Wide-field fundus image from infant ROP screening. Clarity RetCam 3, 130° FOV. 640x480px — 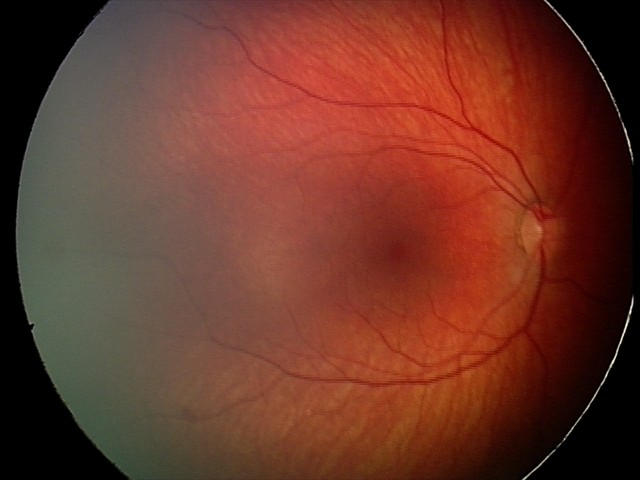

Series diagnosed as retinal hemorrhages.